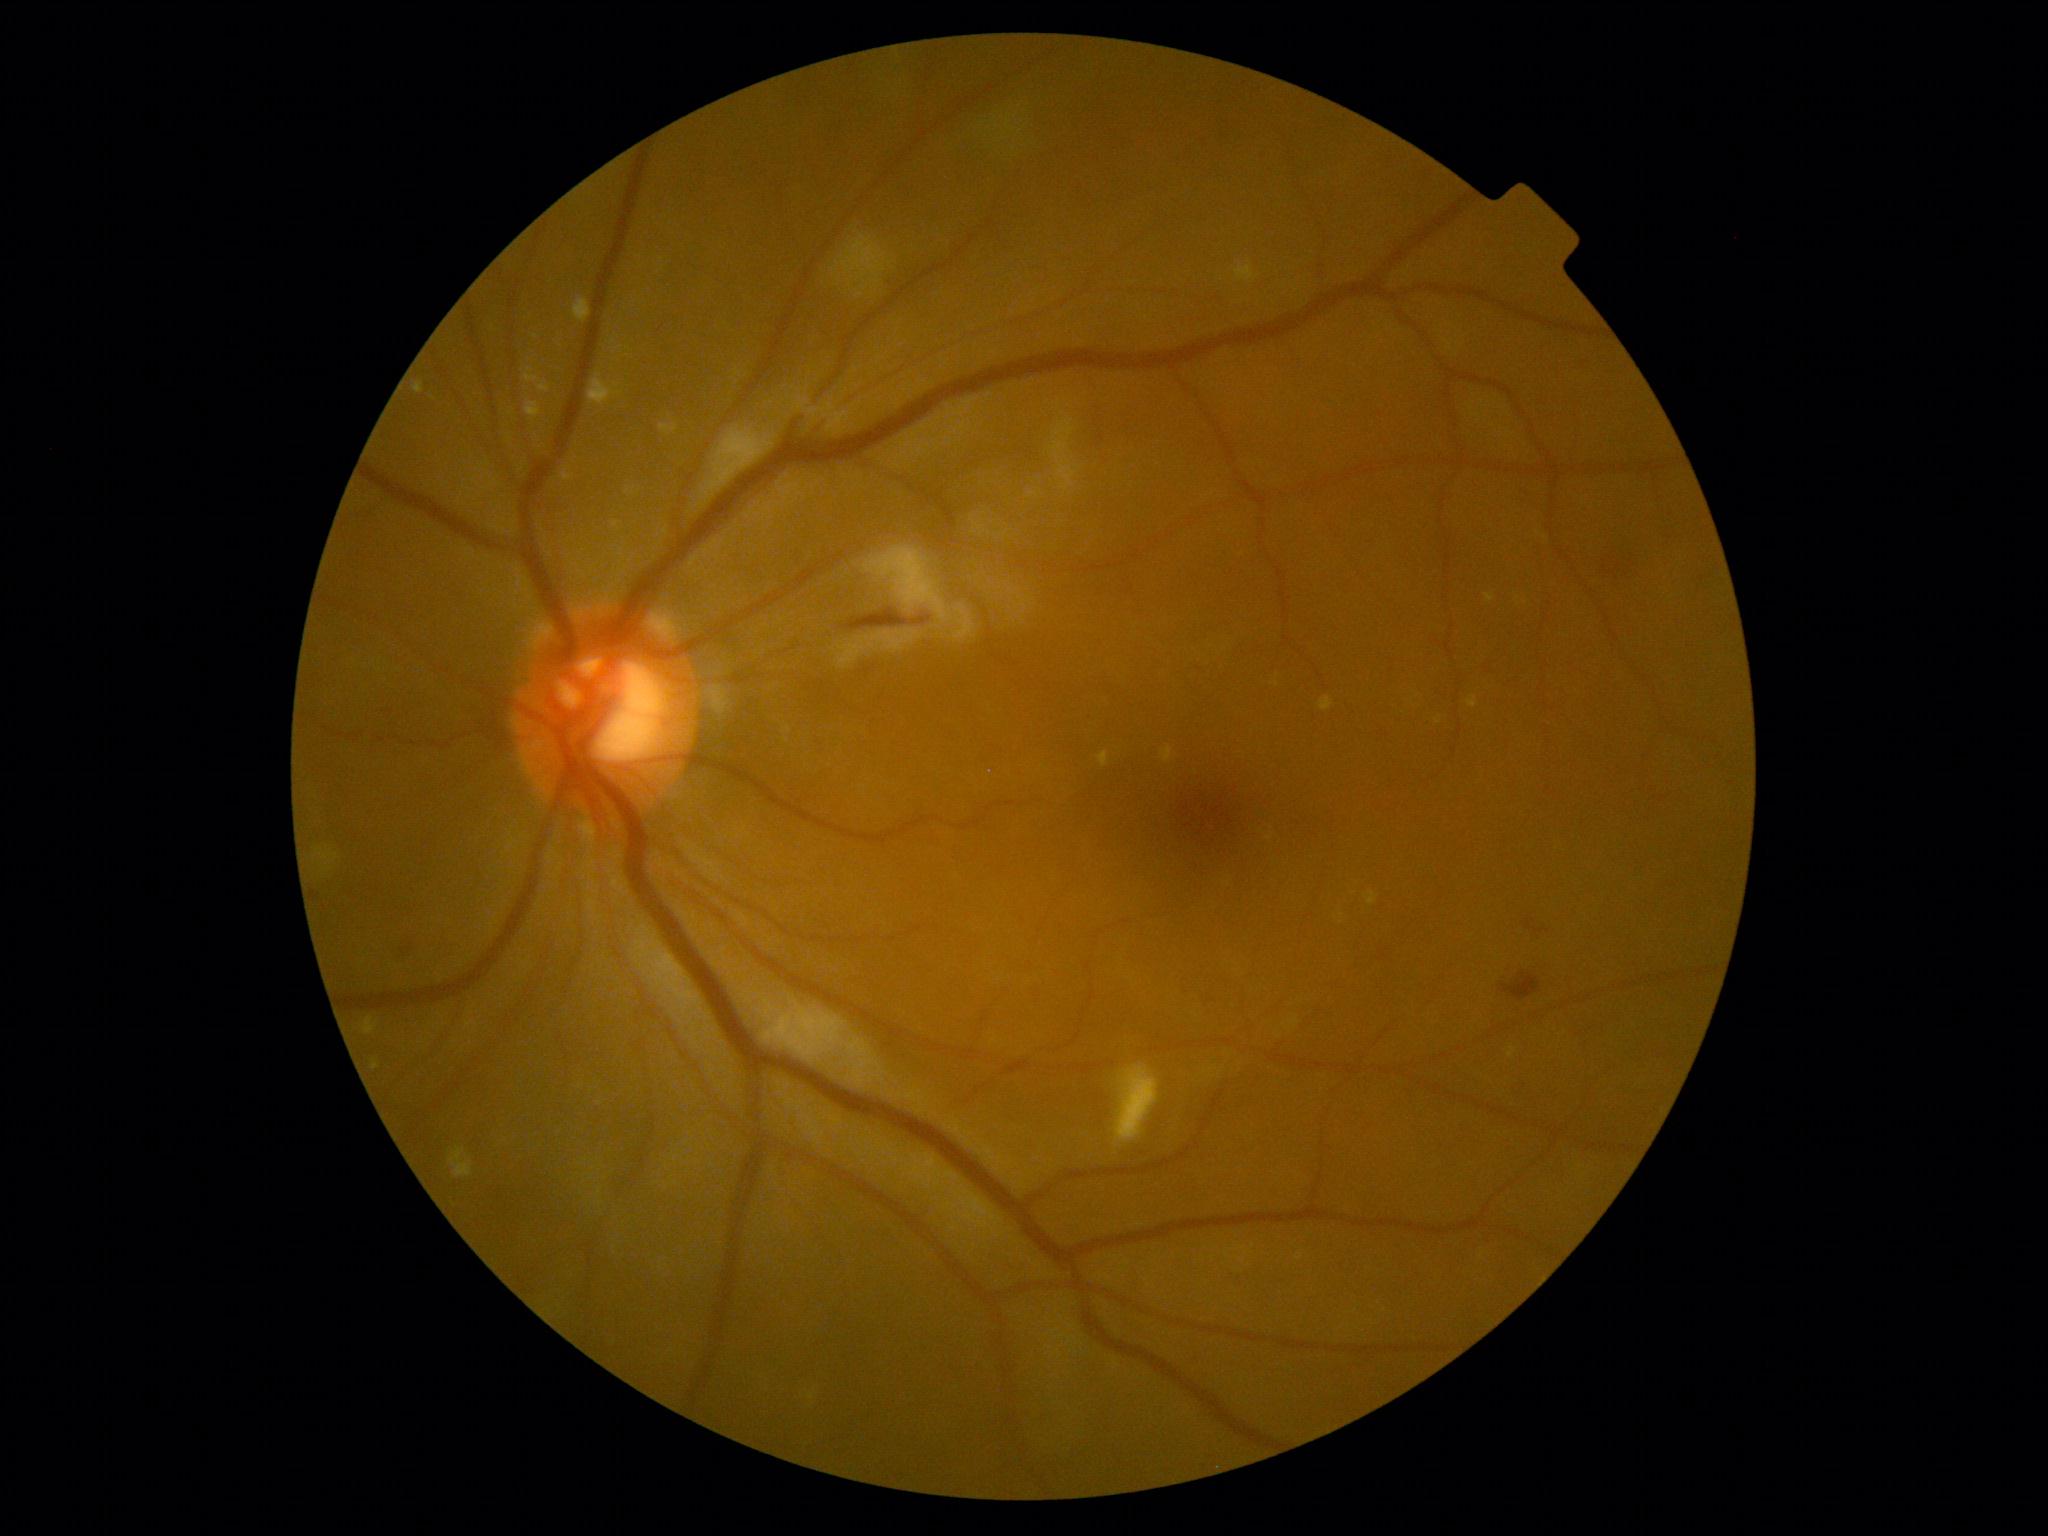
retinopathy grade: 2 — more than just microaneurysms but less than severe NPDR.